848x848px; FOV: 45 degrees; nonmydriatic fundus photograph — 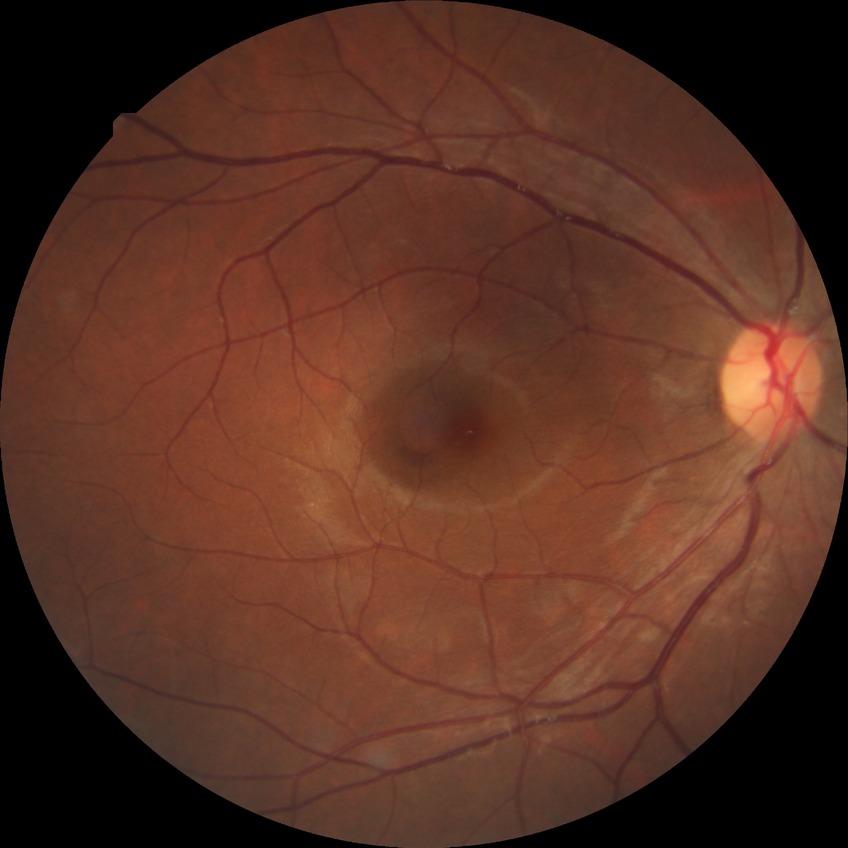

Annotations:
• Davis stage — NDR